Color fundus image:
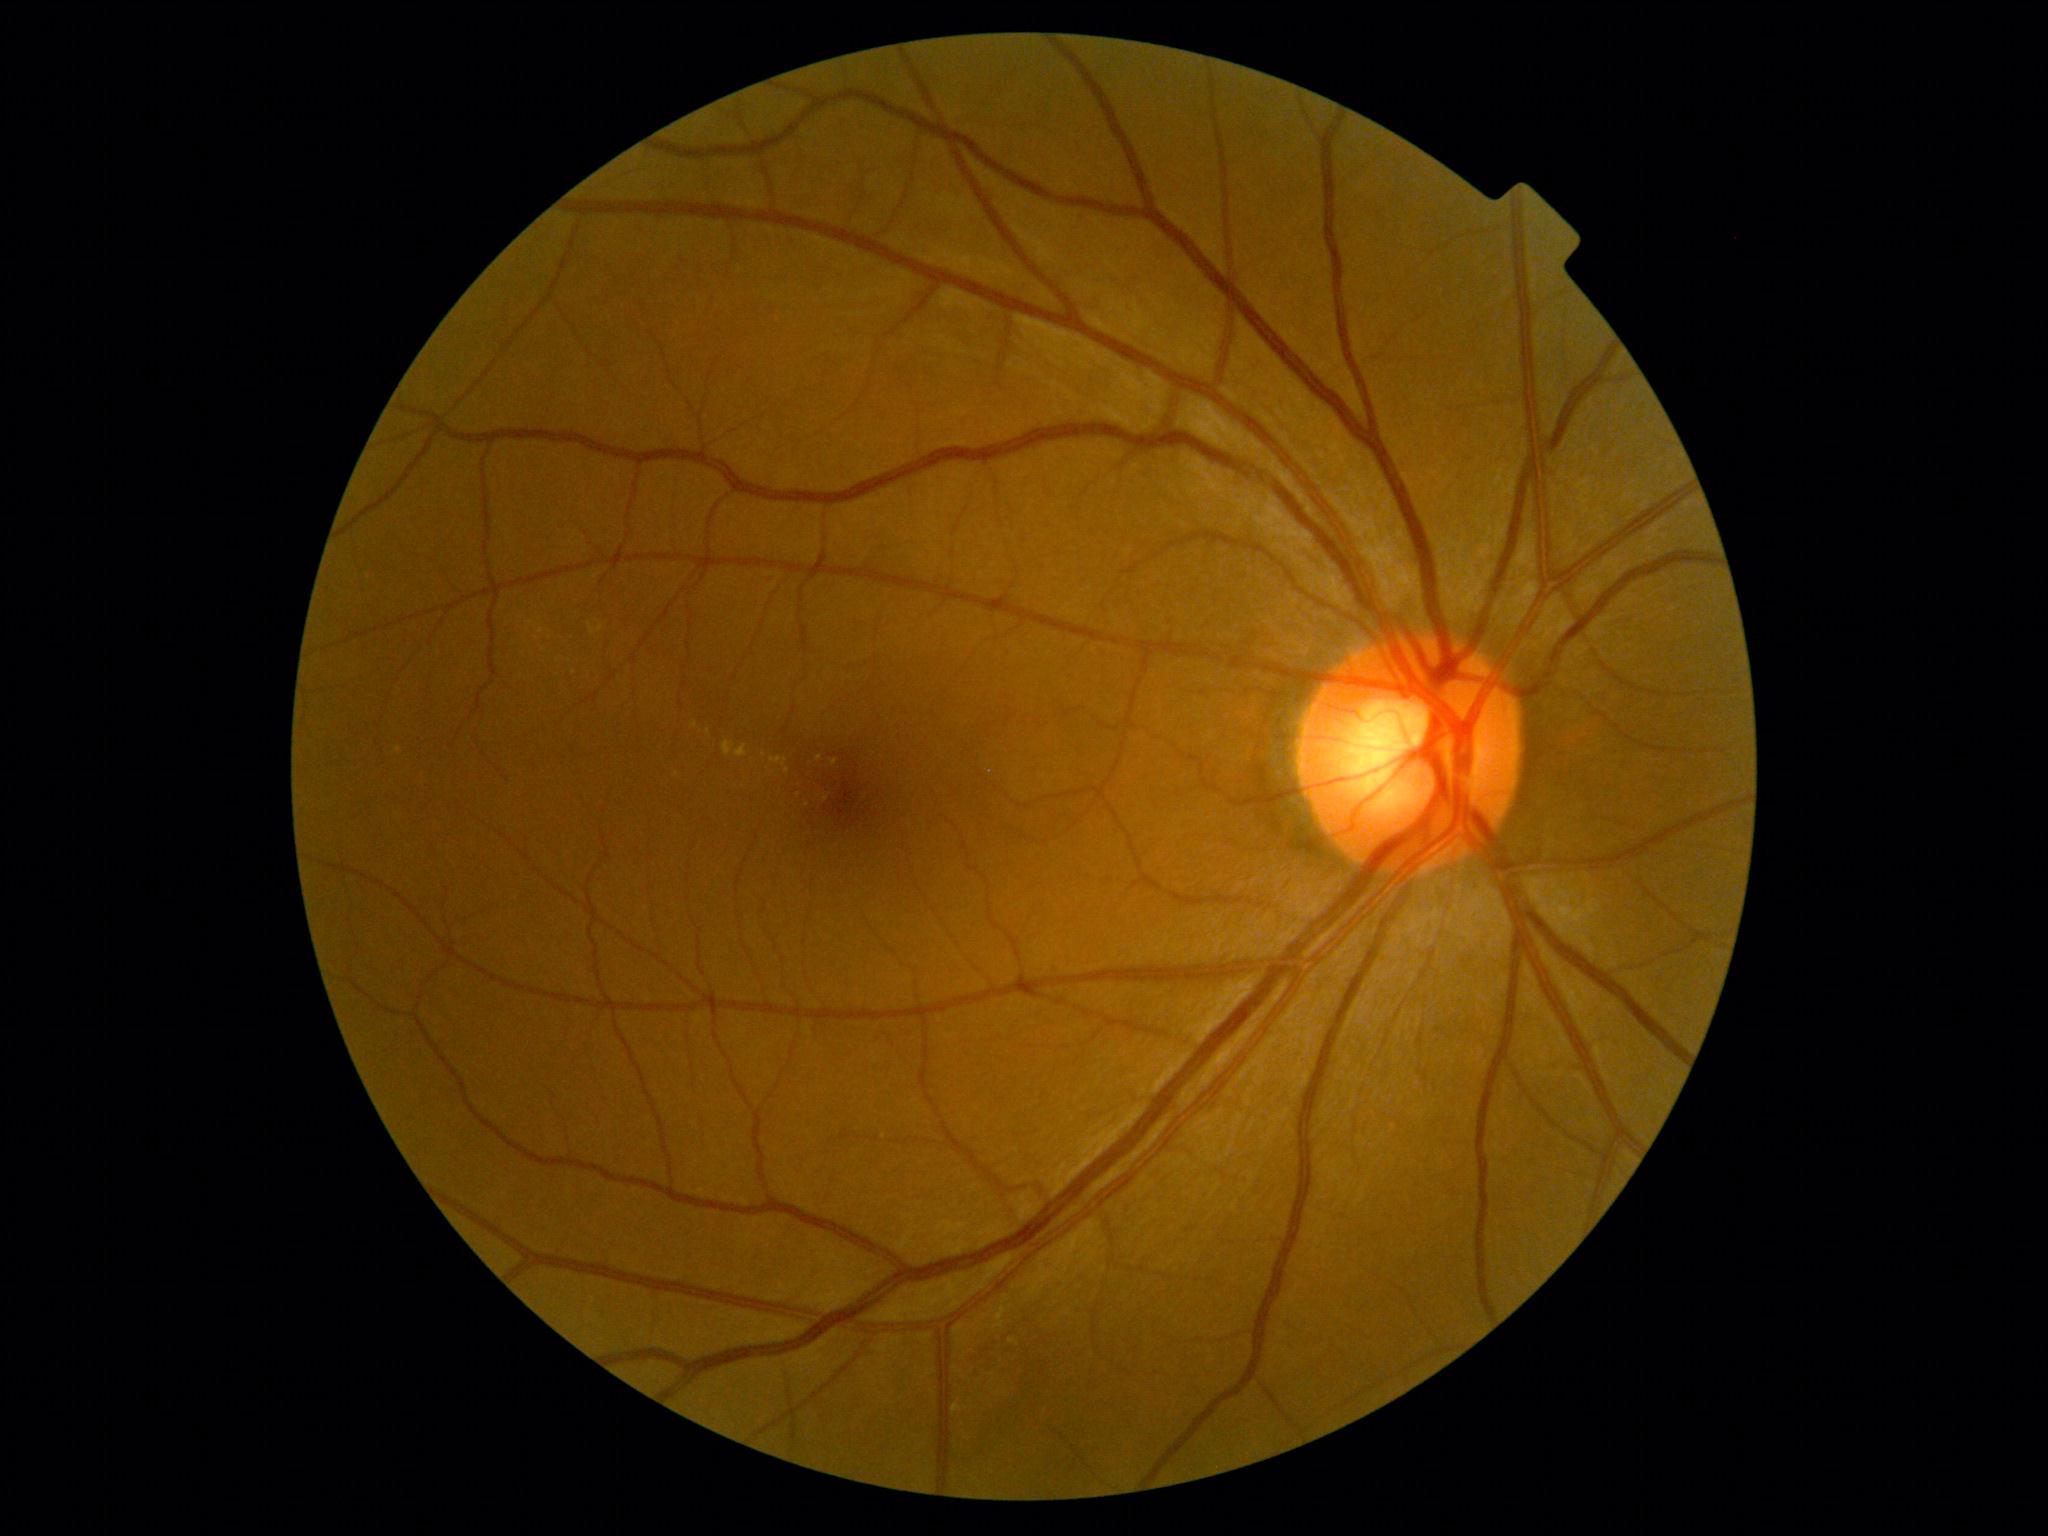
{"dr_grade": "moderate NPDR (grade 2) — more than just microaneurysms but less than severe NPDR"}